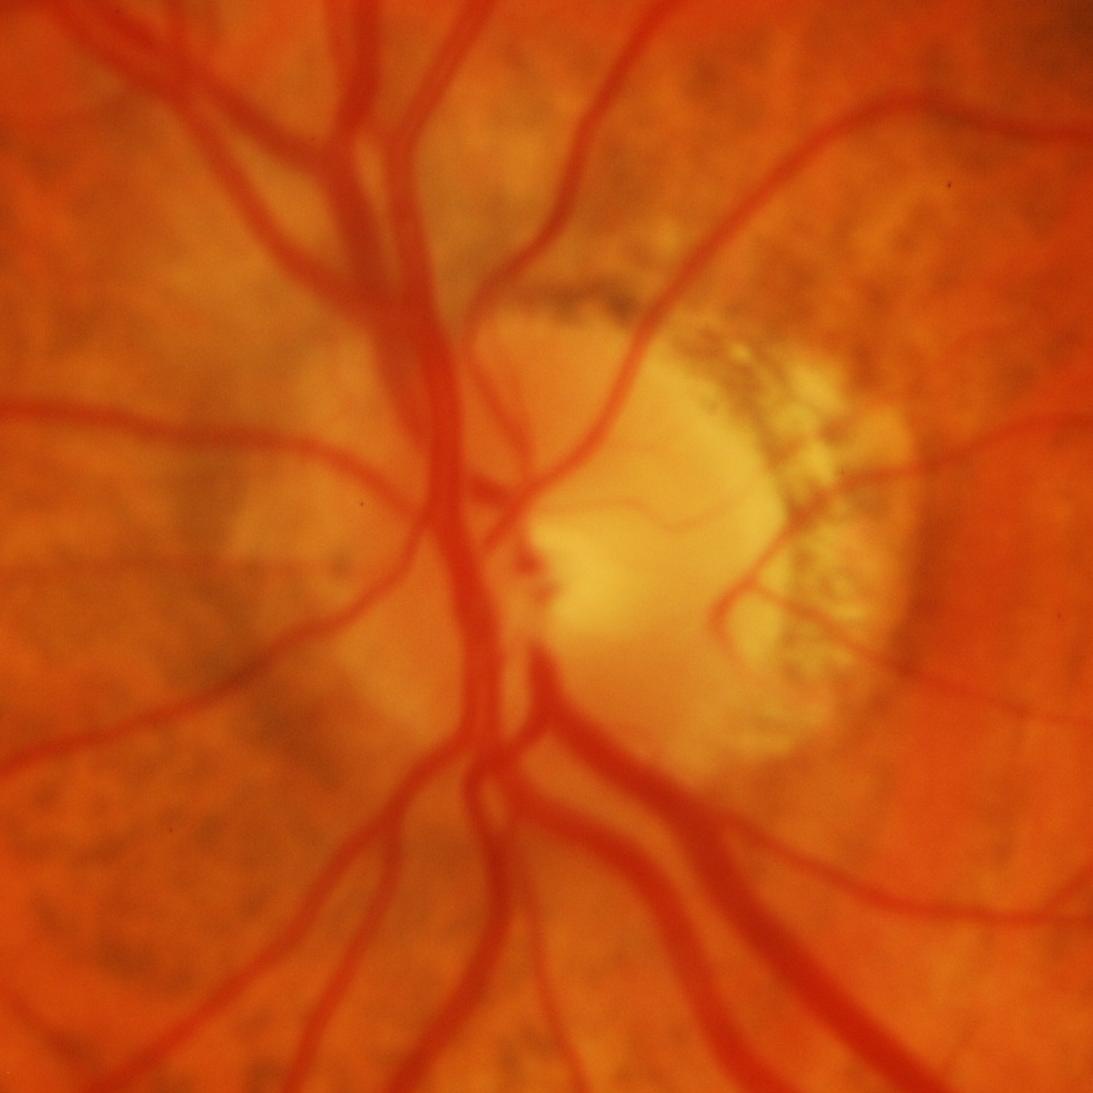

Glaucomatous optic neuropathy is present. Optic nerve head appearance consistent with evidence of glaucoma.